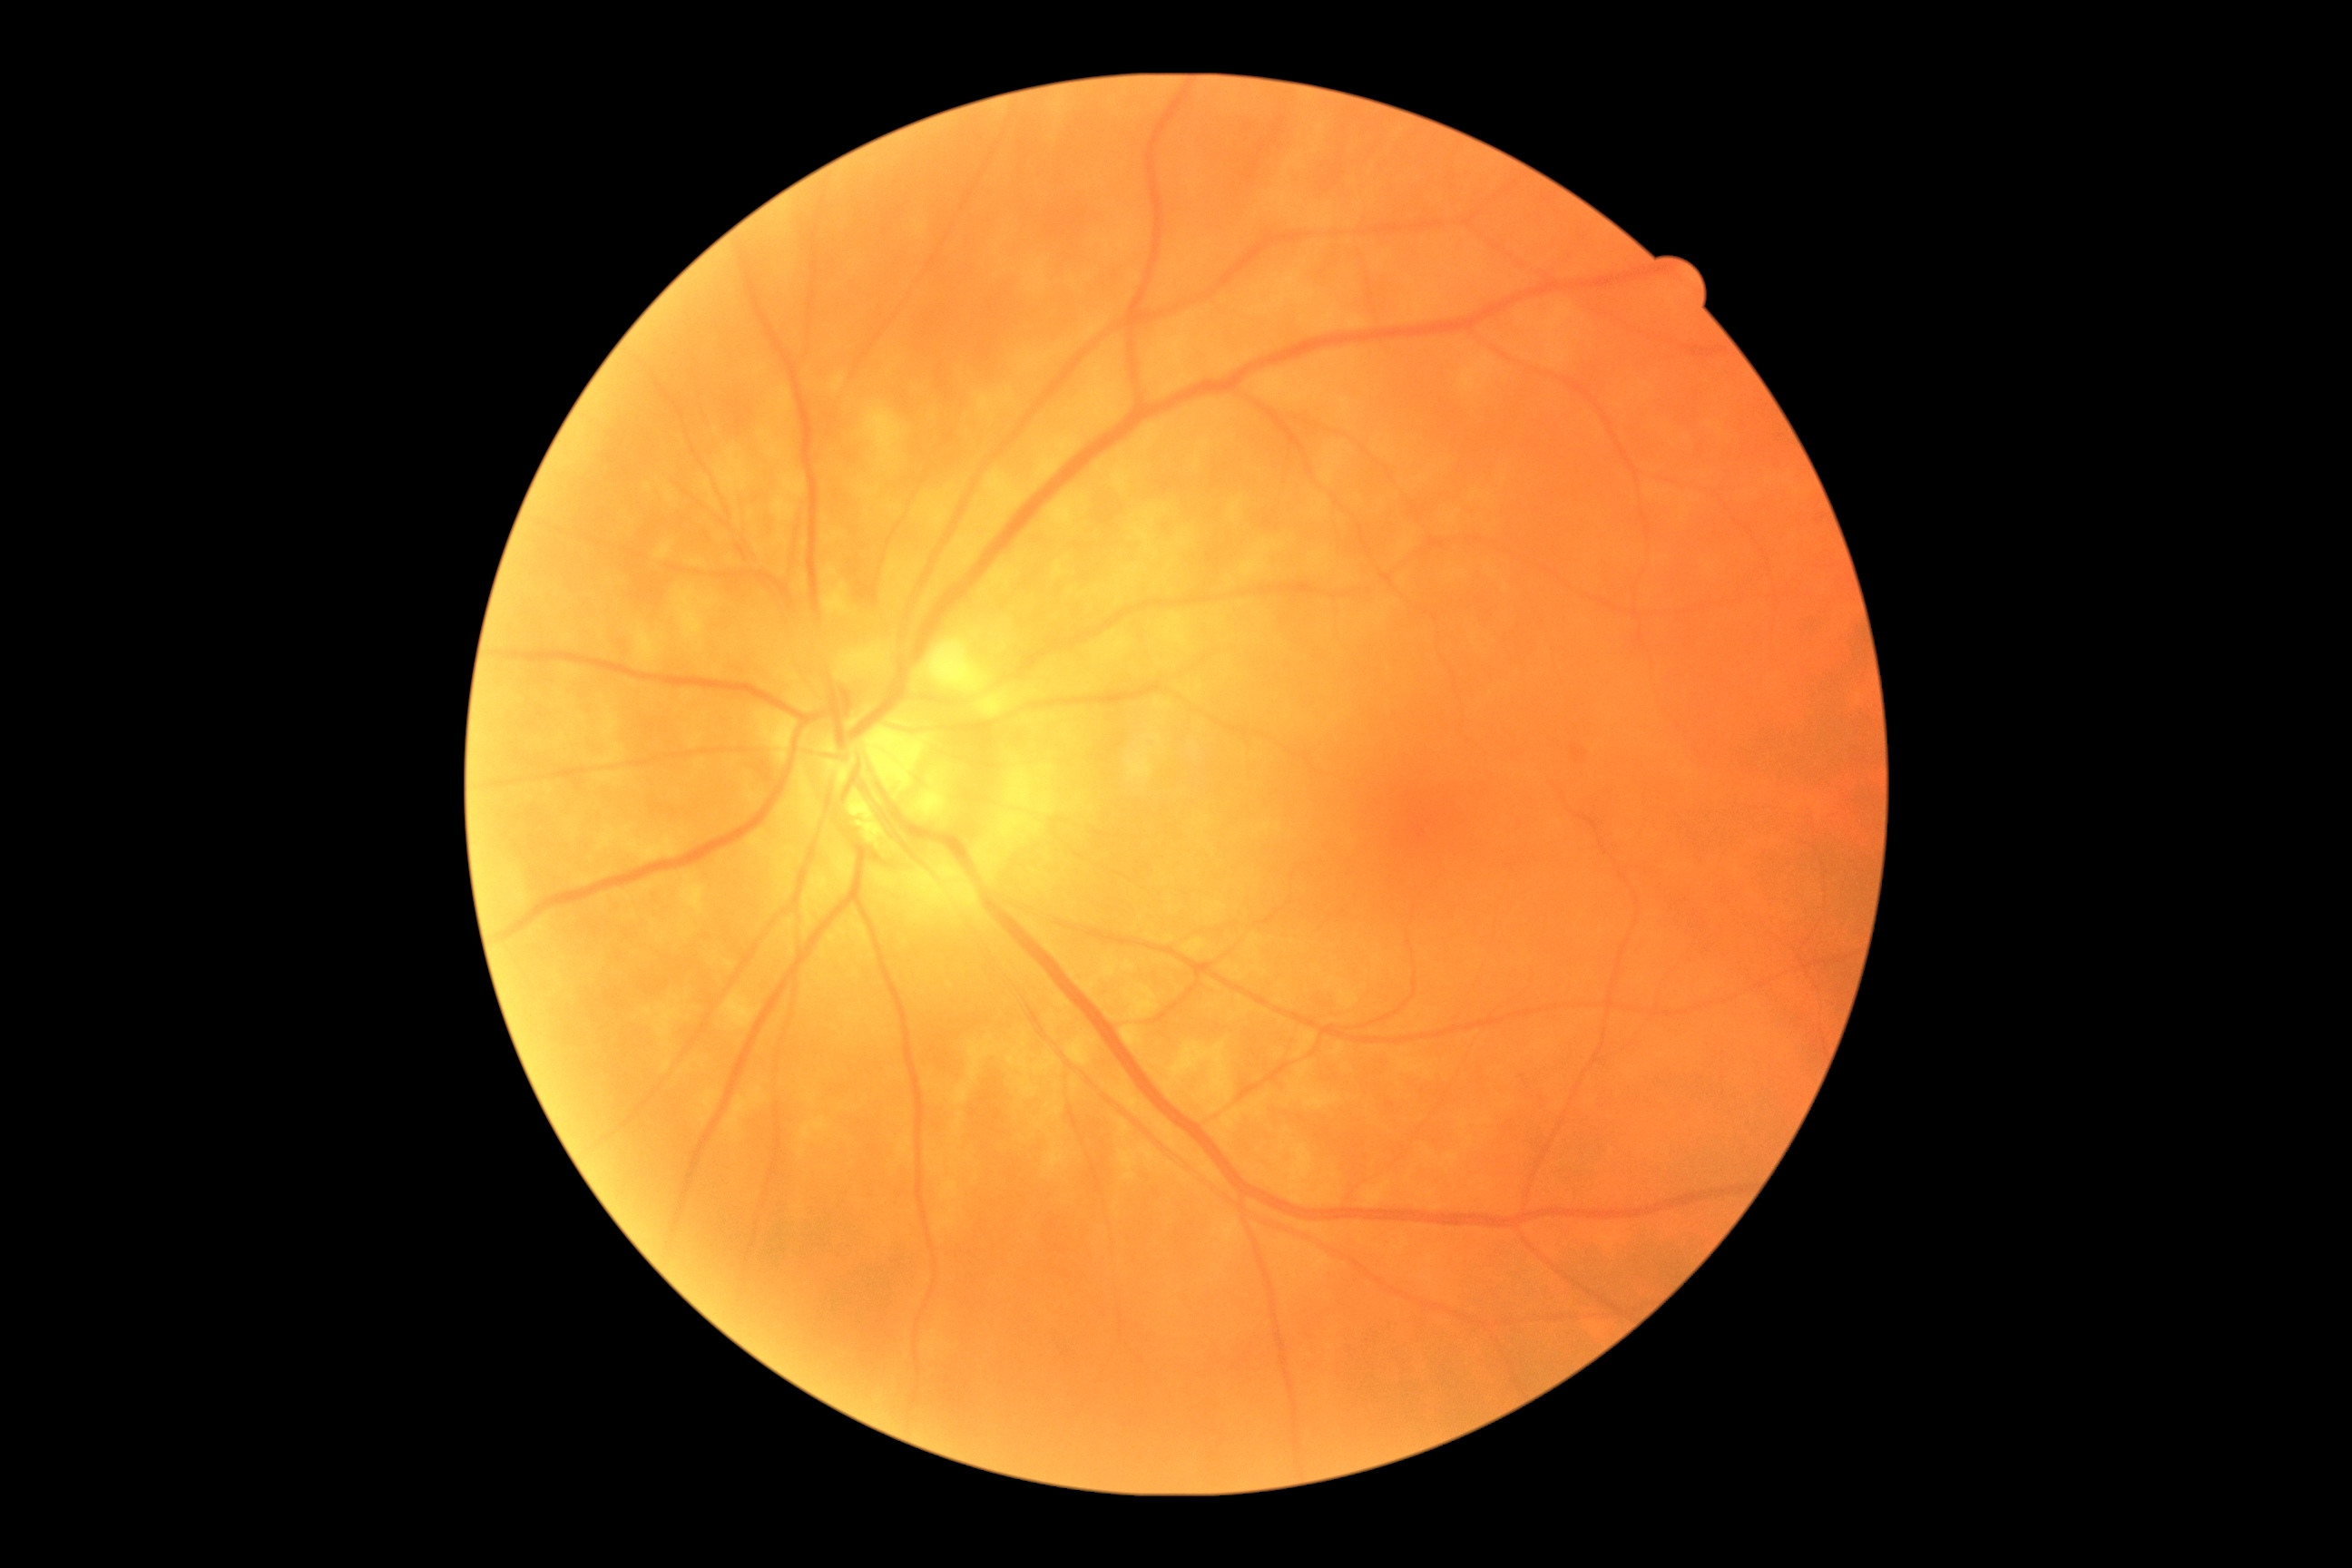

DR stage: grade 1.